Pediatric retinal photograph (wide-field) · 640 by 480 pixels · acquired on the Clarity RetCam 3.
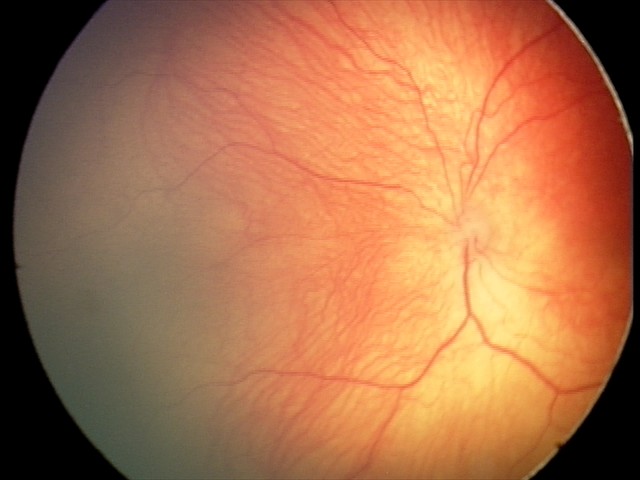

Plus disease absent. Series diagnosed as retinopathy of prematurity stage 2.